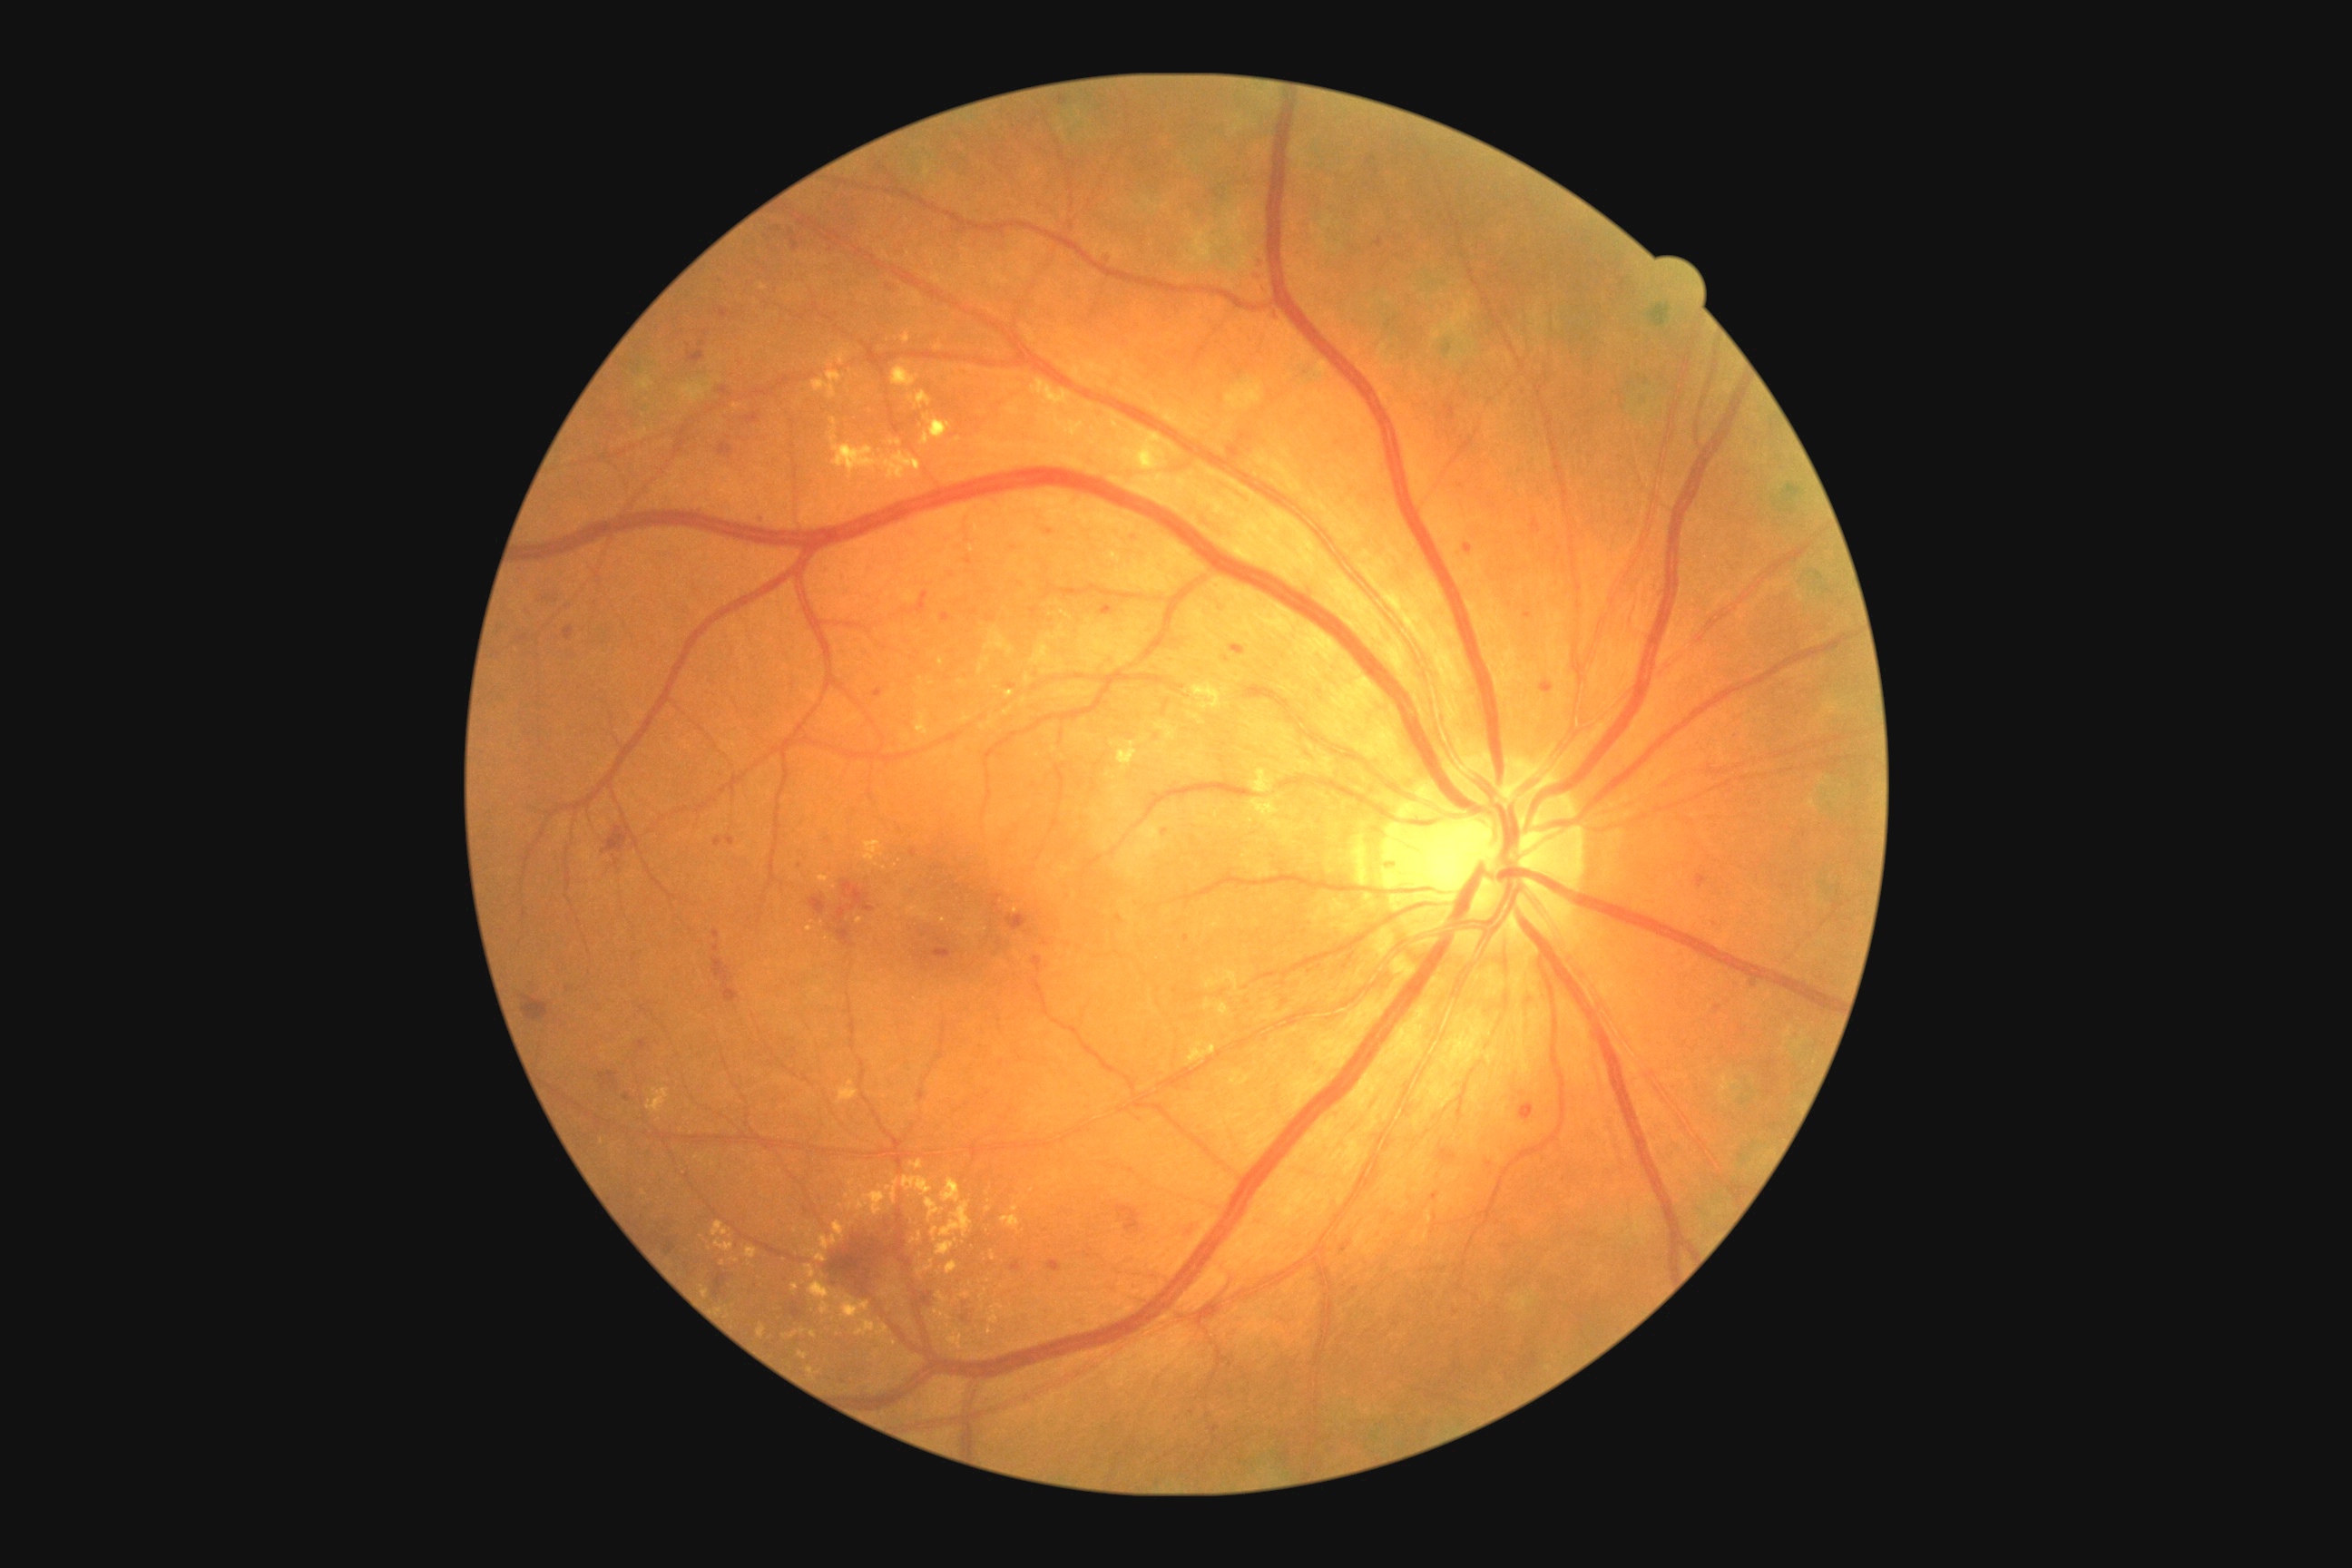

Diabetic retinopathy (DR) is grade 2 (moderate NPDR) — more than just microaneurysms but less than severe NPDR.
Microaneurysms (MAs) include 714 945 720 954 | 1373 239 1384 248 | 916 605 925 614 | 725 836 736 847 | 1485 1161 1493 1168 | 564 627 574 642 | 758 516 767 524 | 1046 529 1054 536 | 750 413 758 424 | 1048 1260 1063 1273 | 770 226 781 231.
Small MAs approximately at (1165; 833) | (1157; 738) | (806; 1210) | (1187; 939) | (973; 613) | (1461; 487).
Hard exudates (EXs) include 910 1161 923 1170 | 1003 1215 1021 1231 | 827 351 850 368 | 936 1293 948 1308 | 901 331 912 344 | 917 391 932 407 | 939 658 945 667 | 1004 691 1014 700 | 1110 741 1139 772 | 839 1297 870 1320 | 941 1202 972 1239 | 838 1081 858 1106.
Small EXs approximately at (601; 1142) | (885; 1294) | (894; 1343) | (841; 1206) | (962; 684) | (990; 1331) | (763; 287).
Hemorrhages (HEs) include 888 286 899 291 | 1518 1102 1534 1122 | 834 881 874 948 | 602 825 629 854 | 522 995 549 1023 | 919 1291 936 1309 | 718 444 732 460 | 687 351 705 364 | 1438 1144 1458 1166 | 1032 957 1043 974 | 745 413 760 424 | 712 1273 729 1297.